RetCam wide-field infant fundus image · camera: Clarity RetCam 3 (130° FOV)
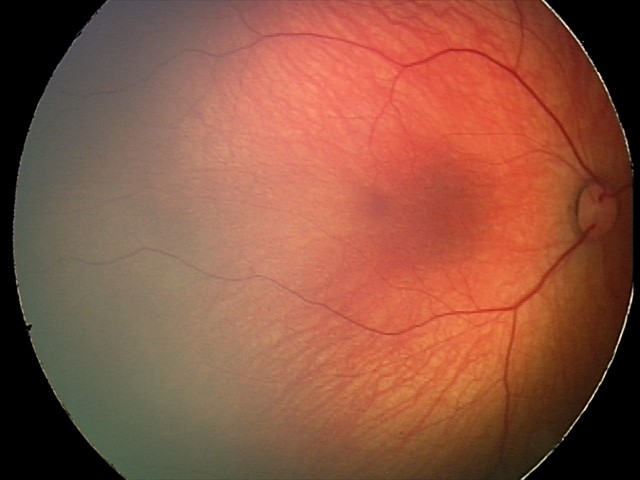 Screening series with retinal hemorrhages.